2102x1736:
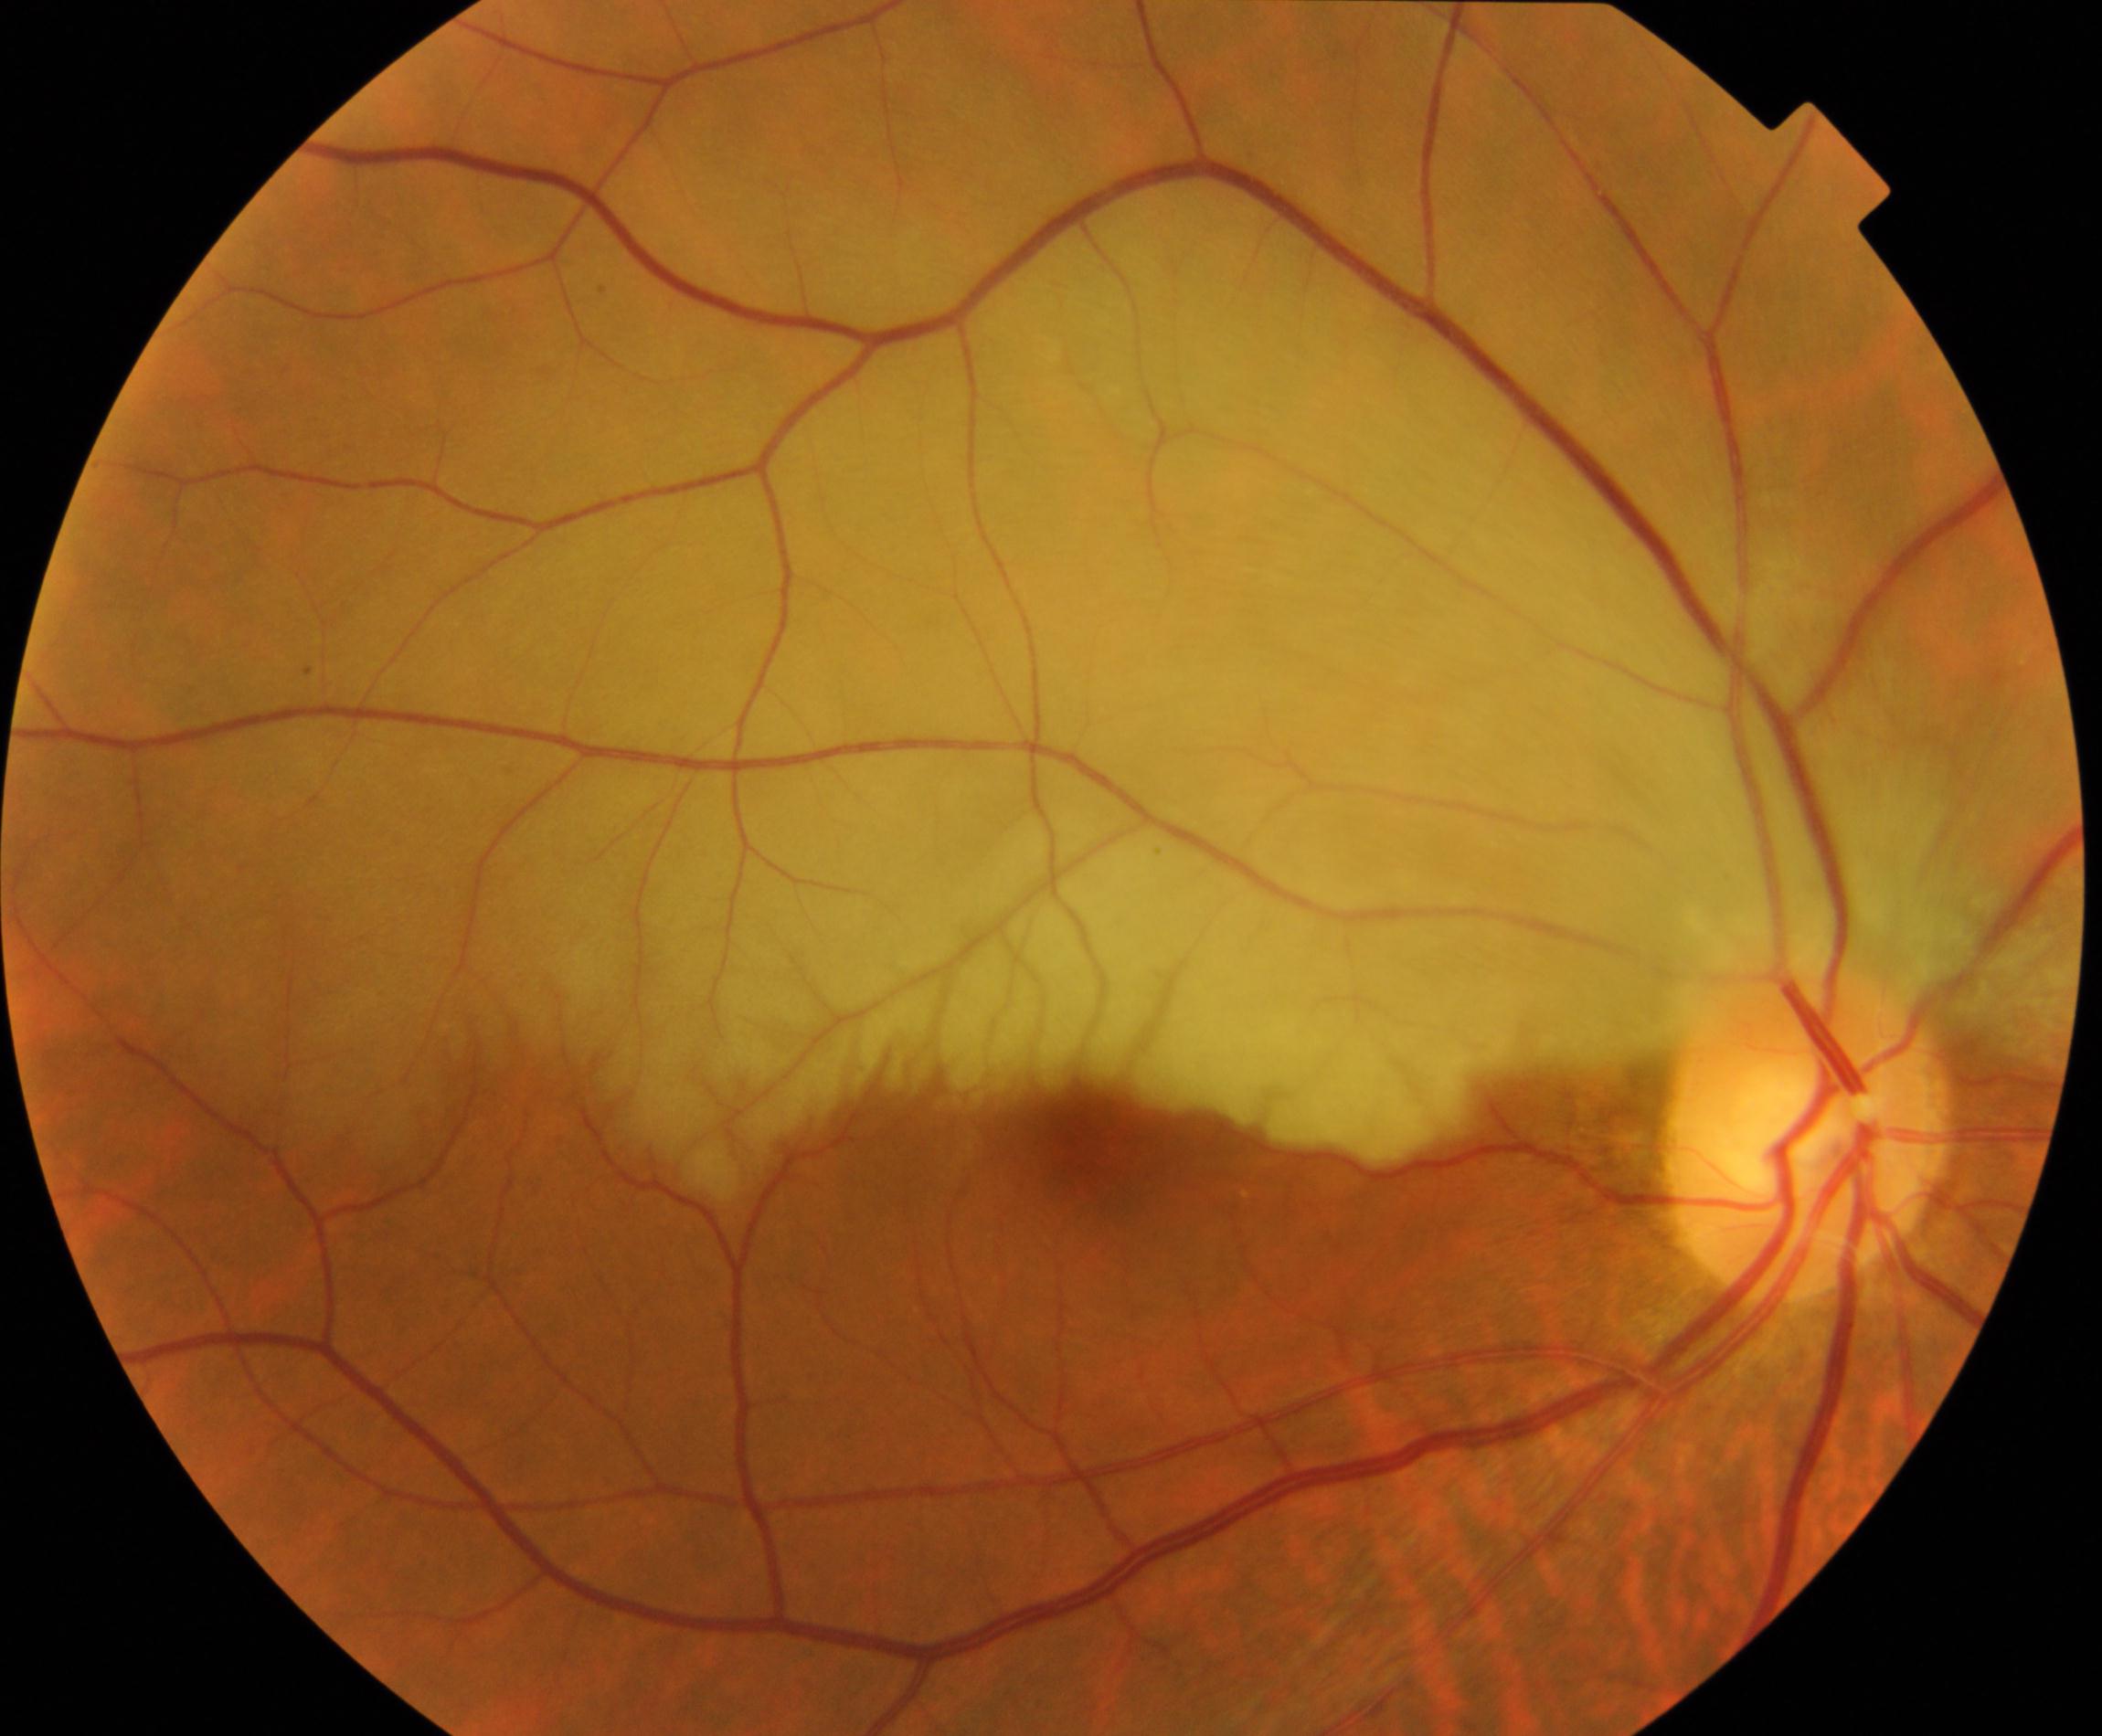 Color fundus photograph showing retinal artery occlusion.